Graded on the modified Davis scale.
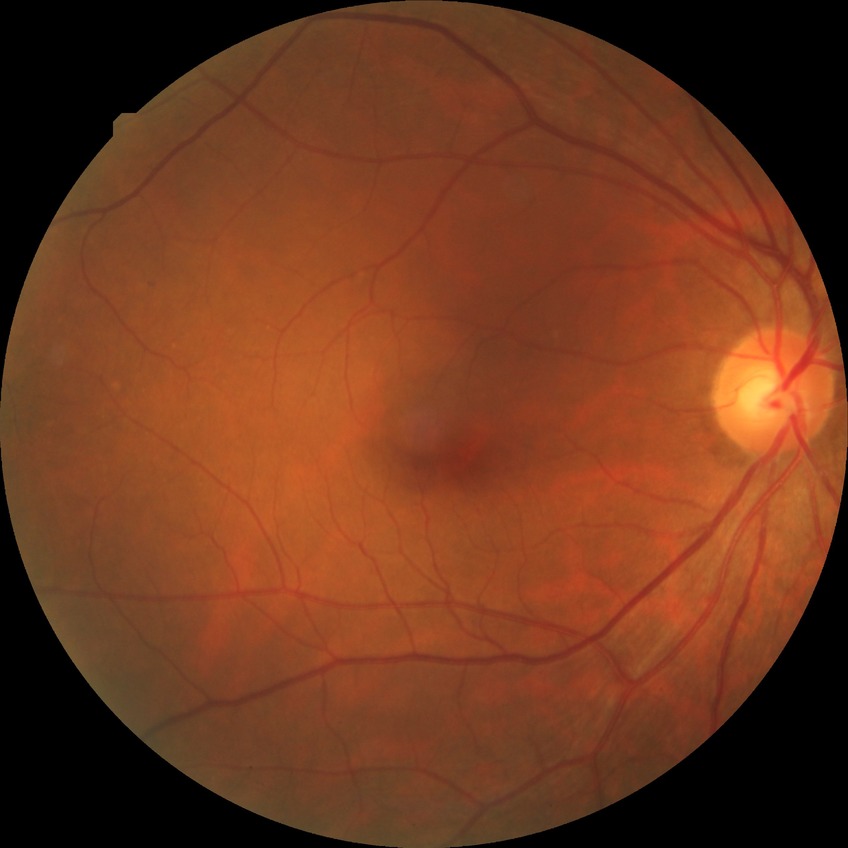 Retinopathy grade: no diabetic retinopathy.